Color fundus photograph.
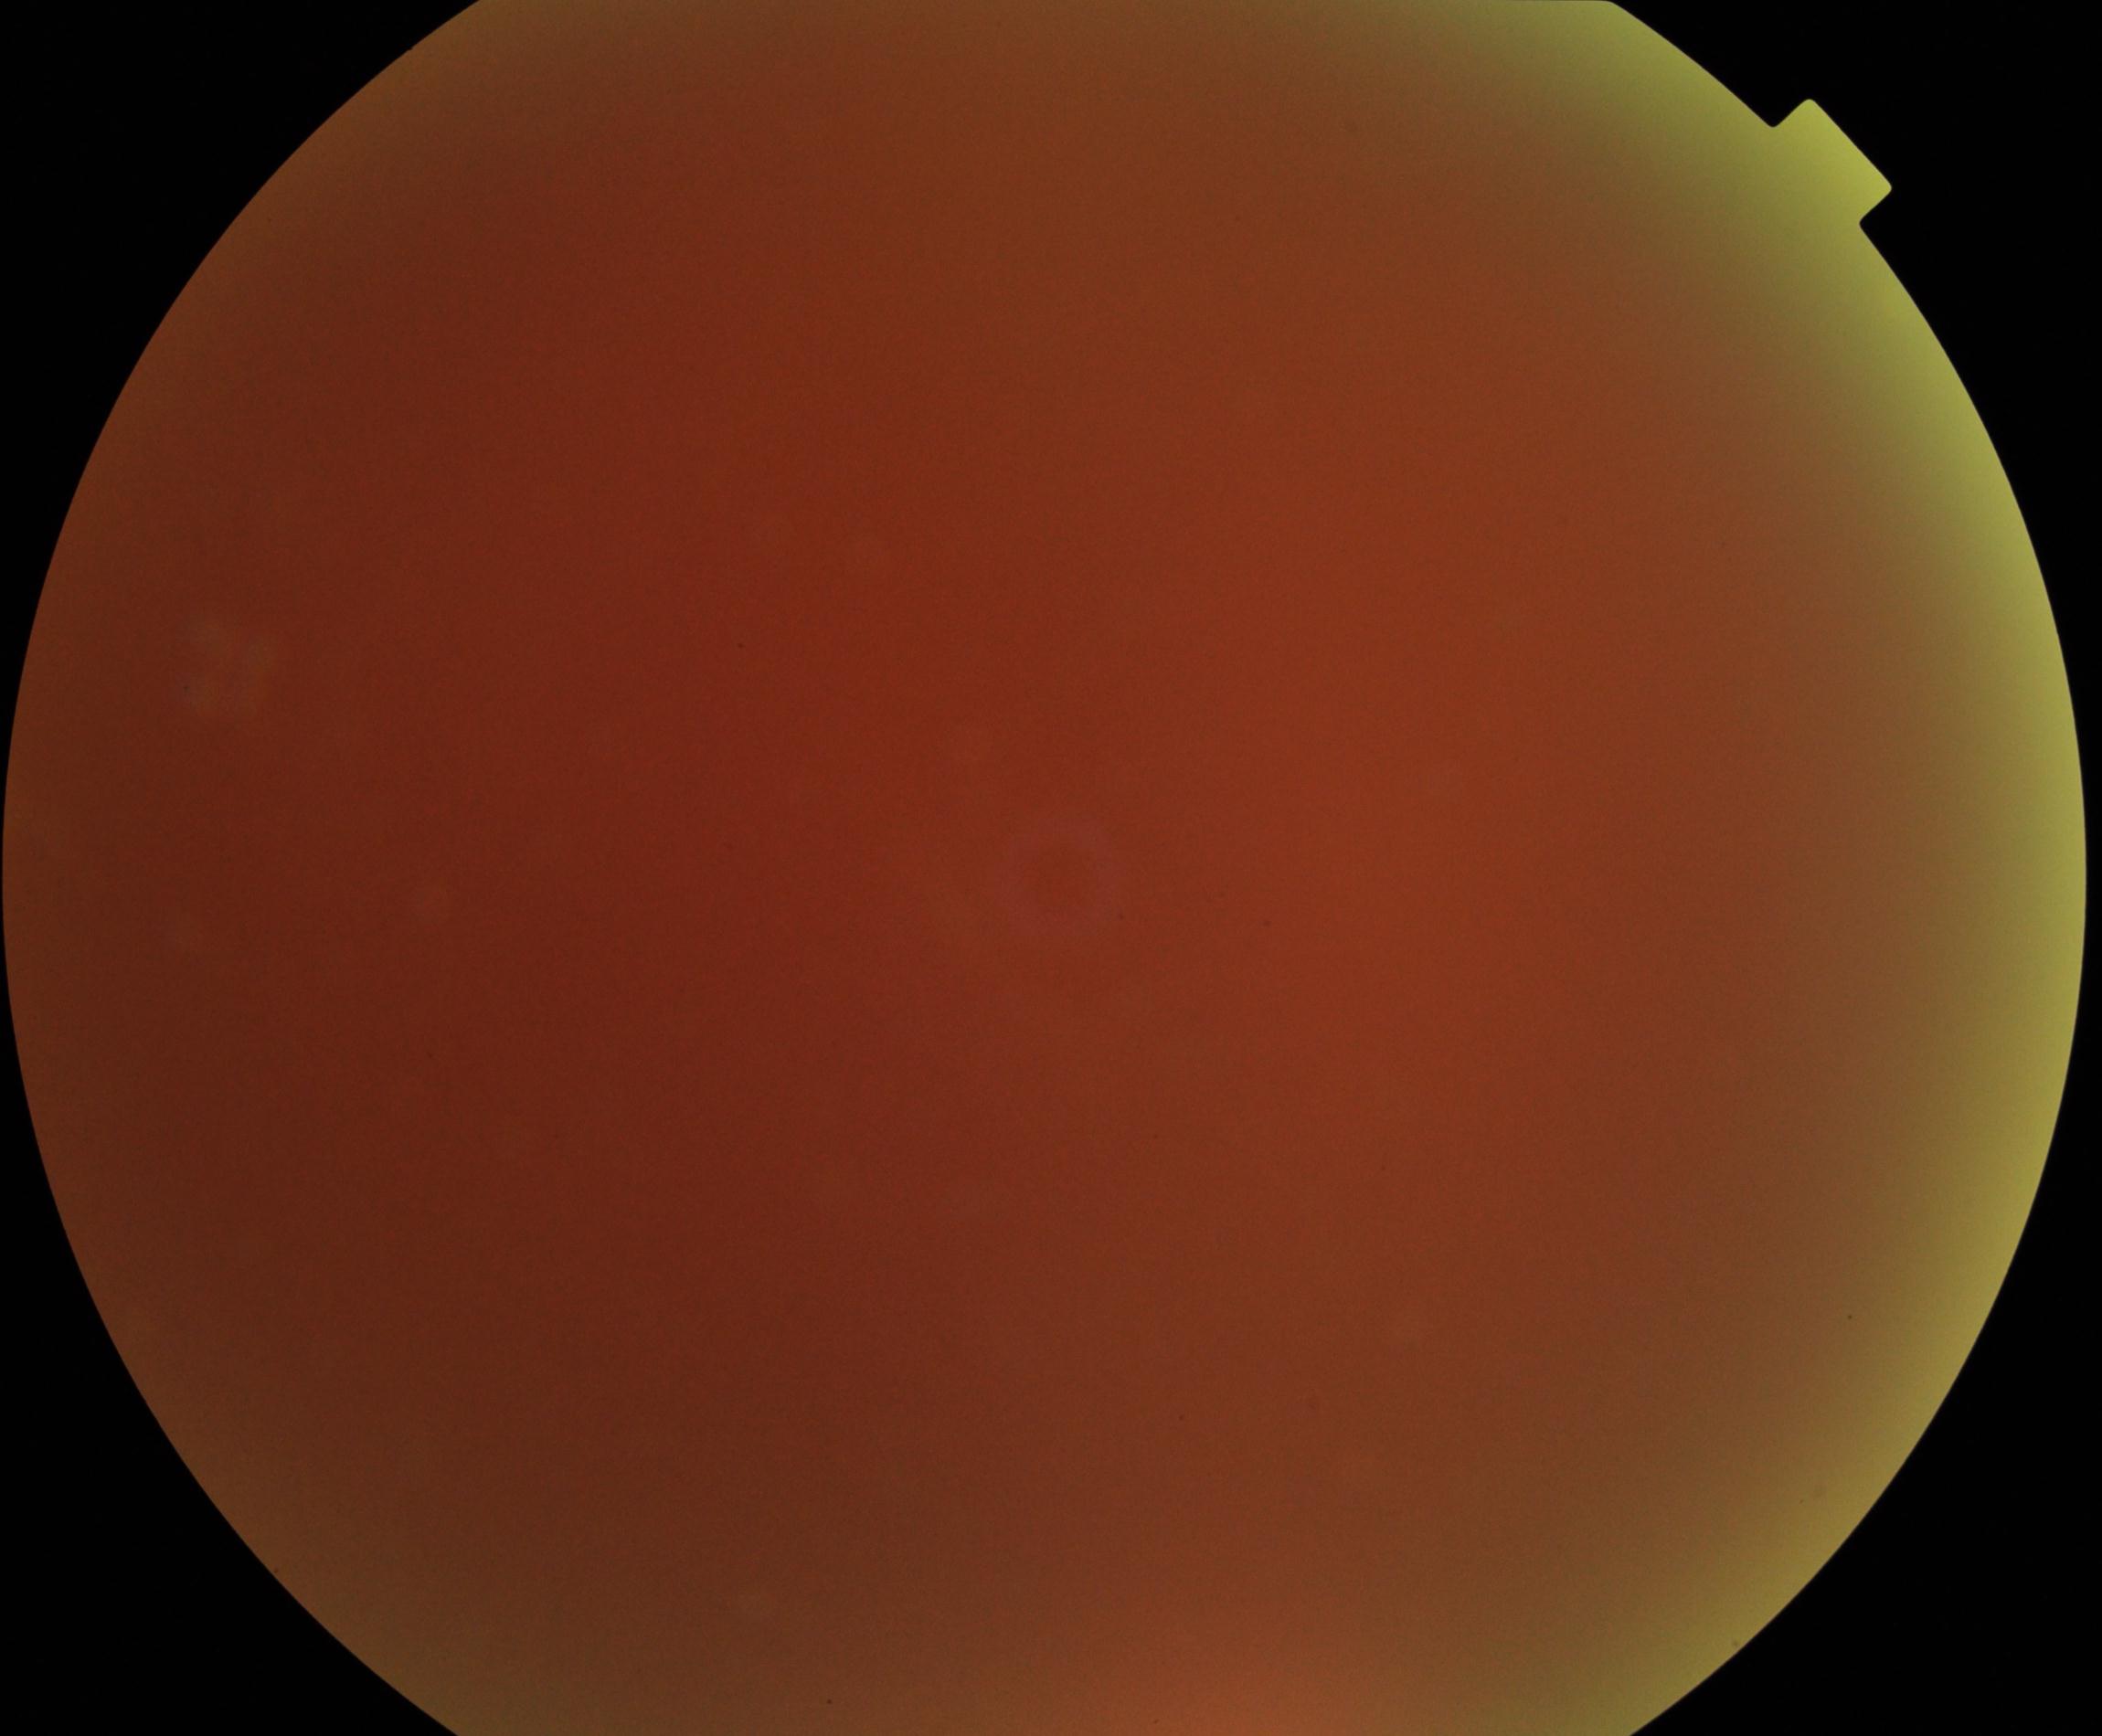
Significantly degraded image quality with obscured retinal detail. Proliferative diabetic retinopathy not identified in the visible portion.